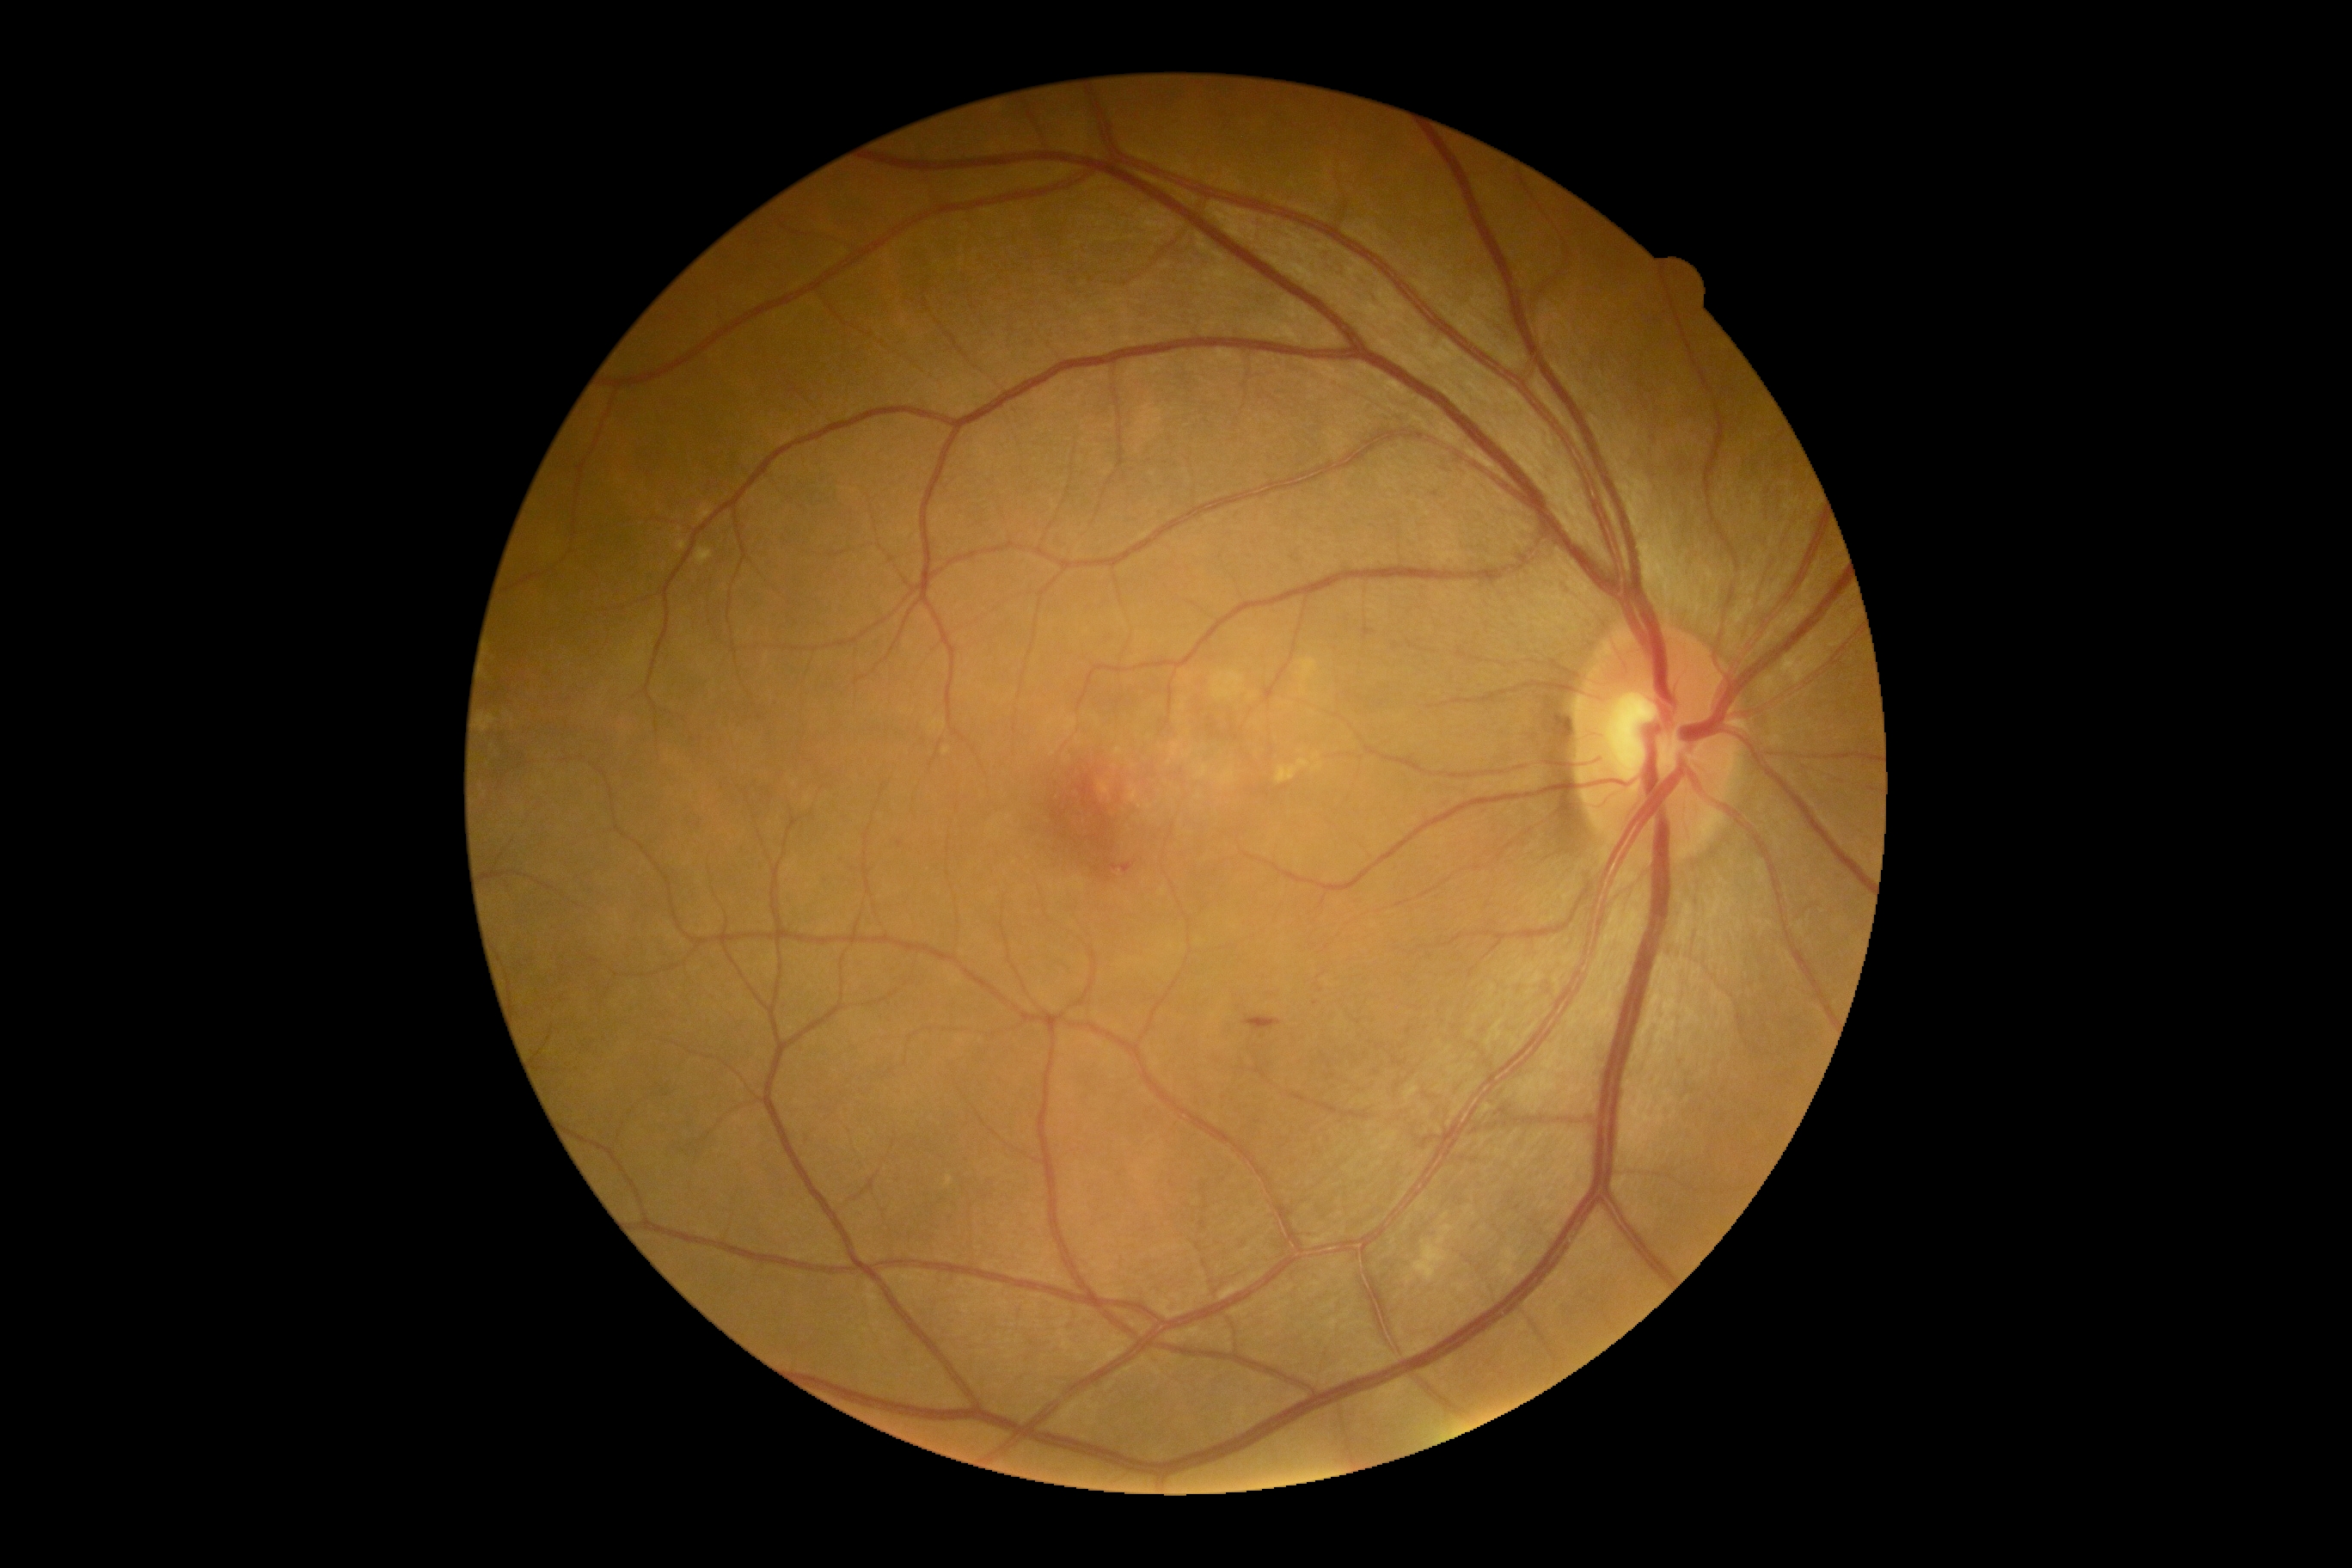 DR severity is moderate NPDR (grade 2).